848x848; no pharmacologic dilation; NIDEK AFC-230 fundus camera; fundus photo: 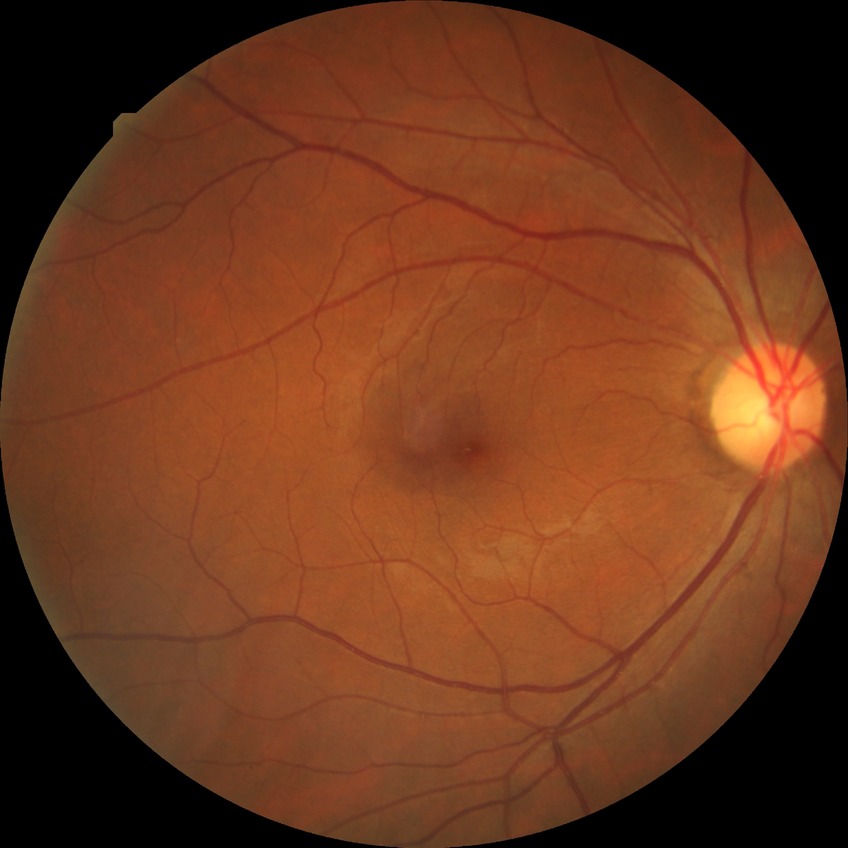

diabetic retinopathy (DR): no diabetic retinopathy (NDR).